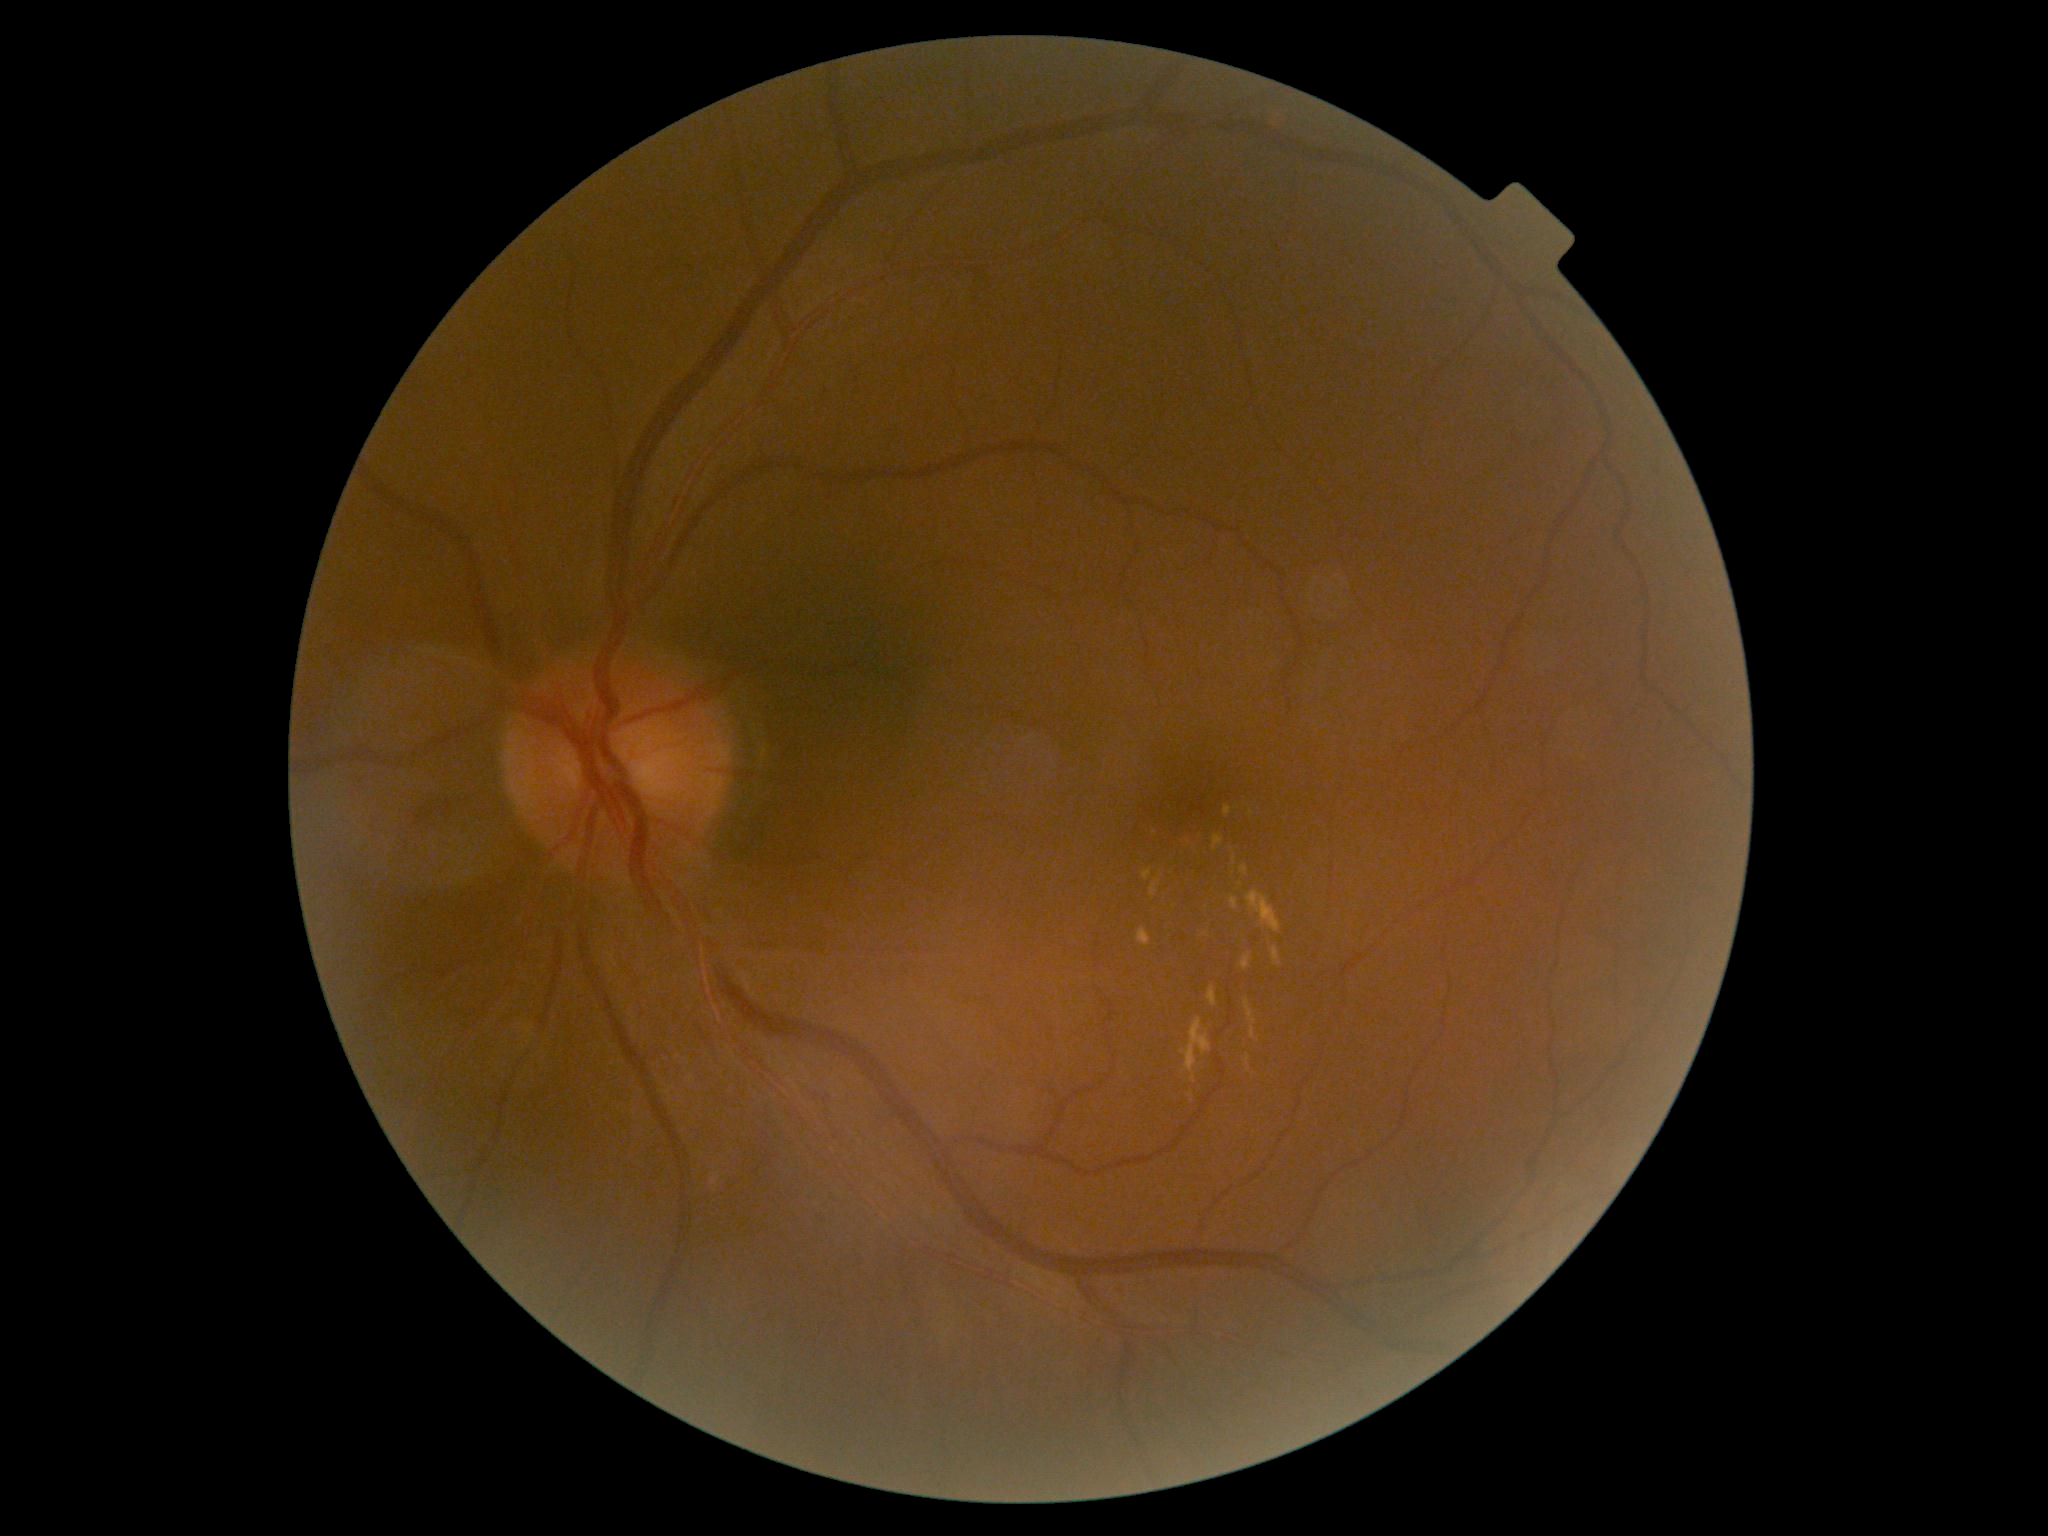

DR stage: moderate non-proliferative diabetic retinopathy (grade 2).